2352x1568px:
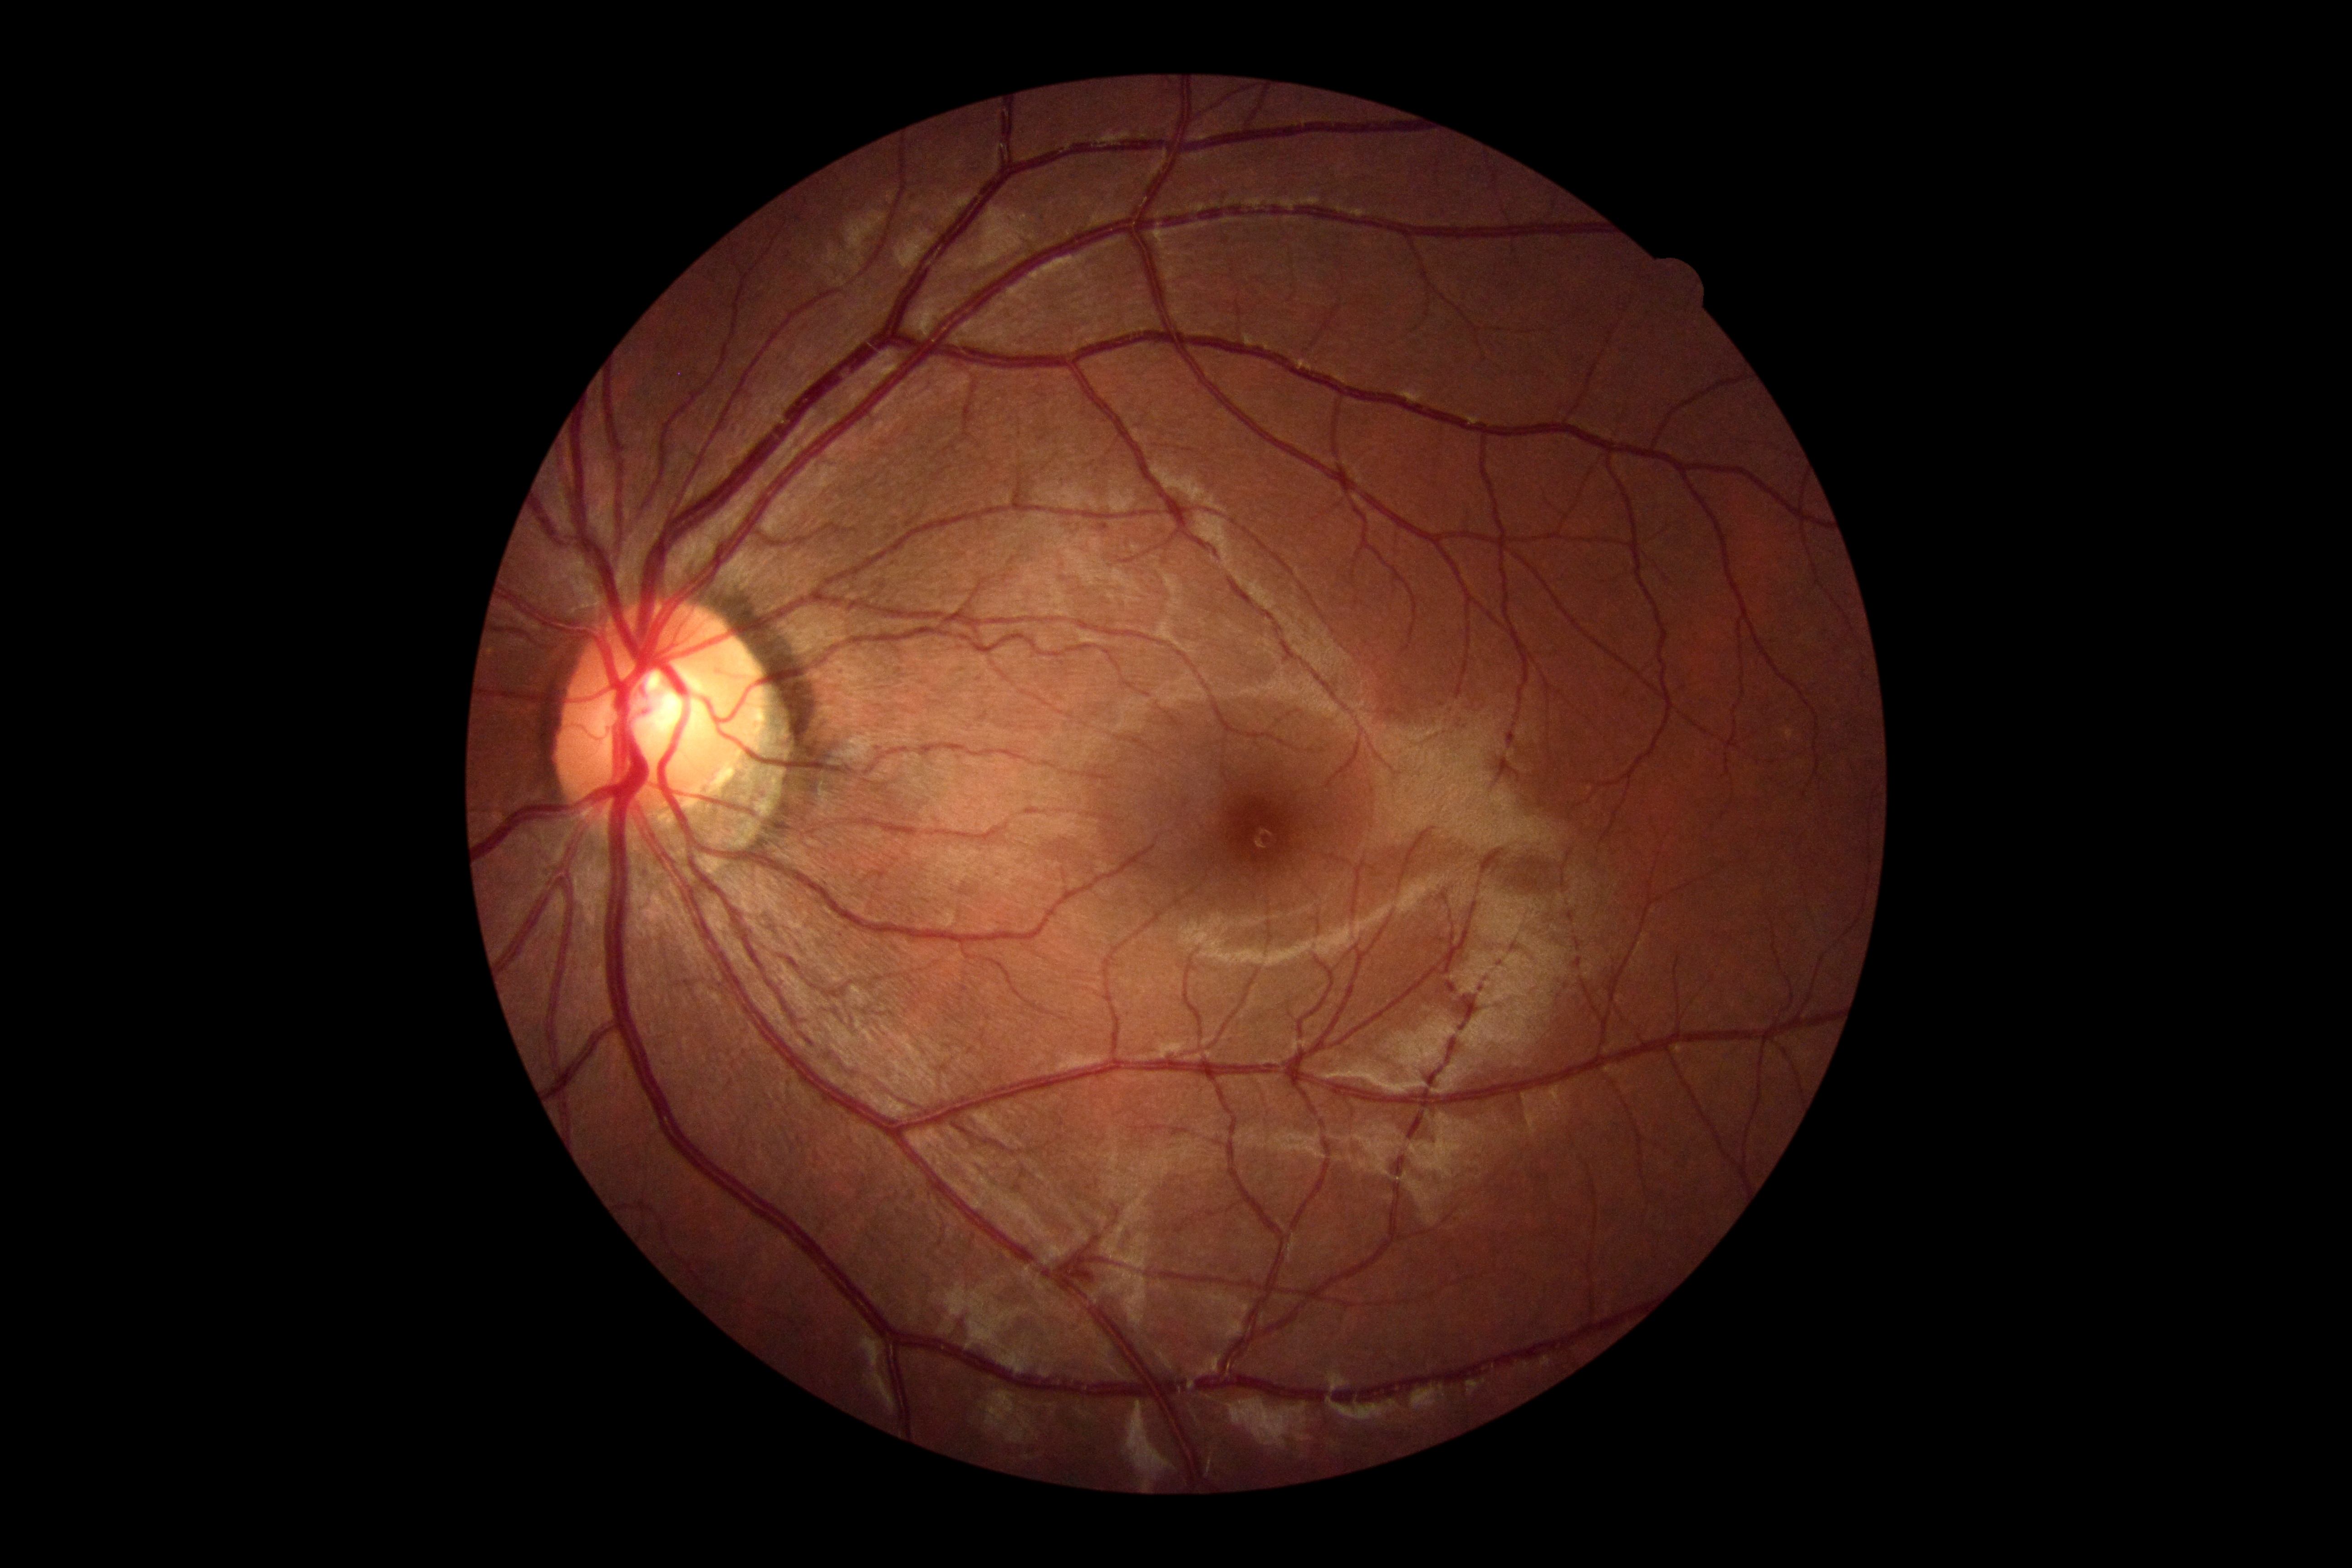
DR stage@0.